412x310px · color fundus image:
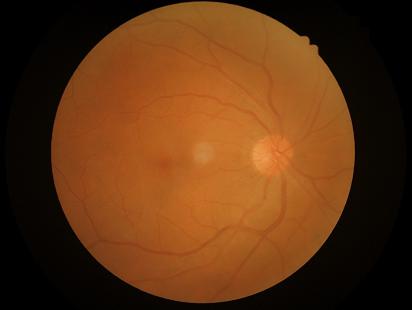   contrast: satisfactory
  illumination: good
  overall_quality: good
  clarity: in focus